1440x1080; pediatric retinal photograph (wide-field).
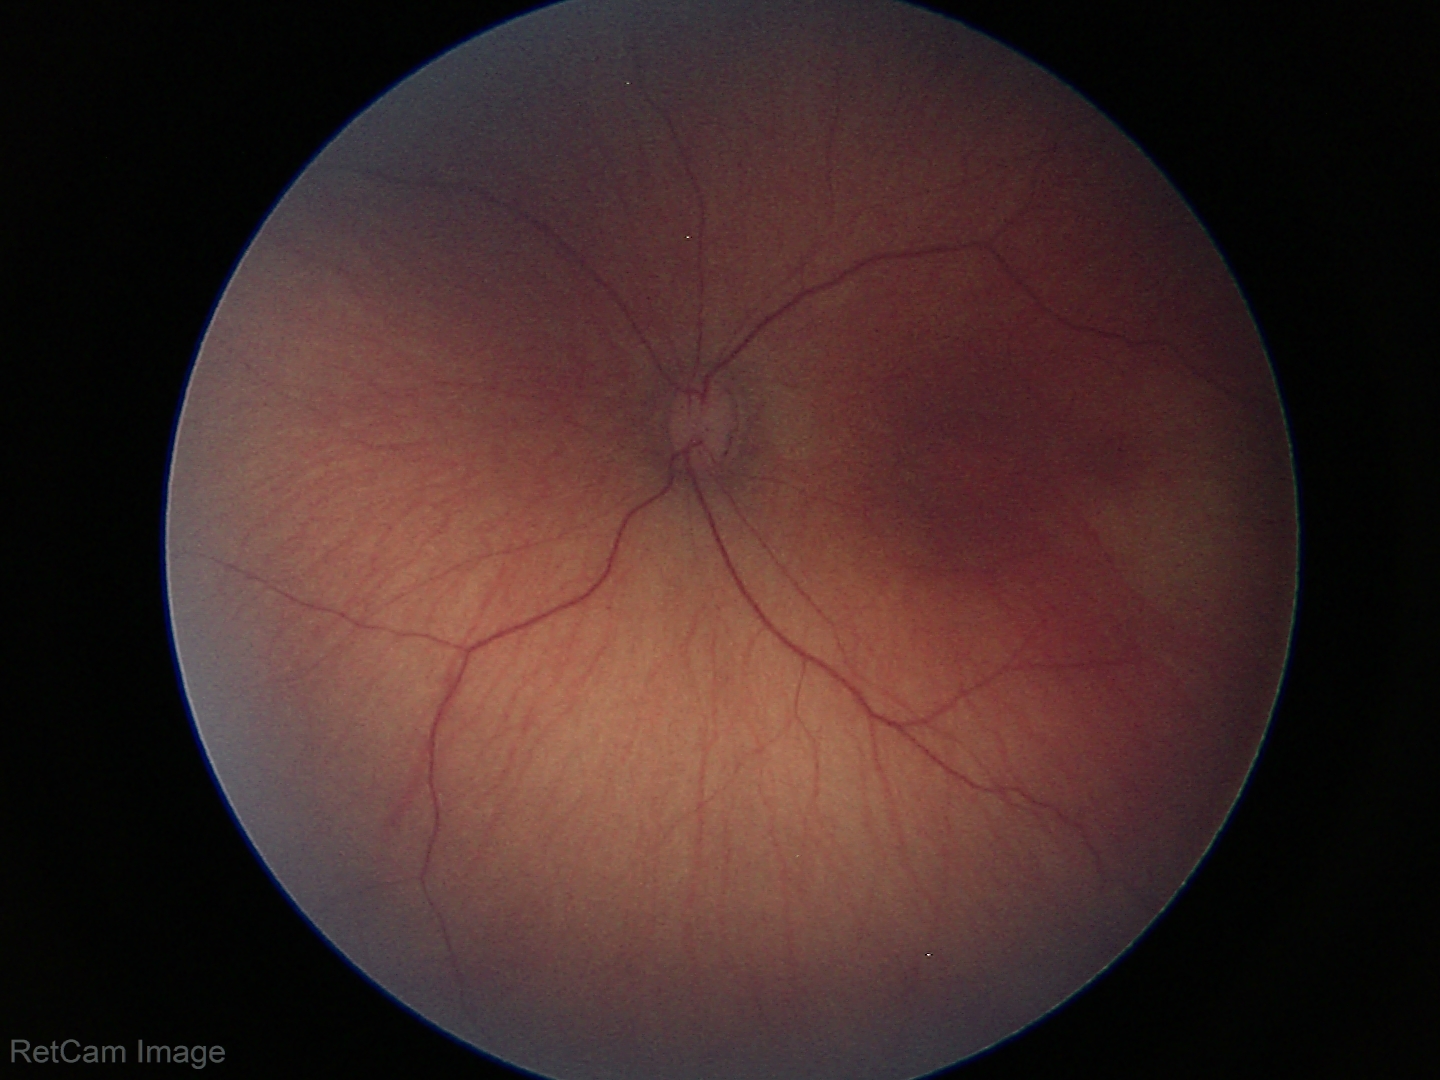 Assessment = physiological appearance.